Color fundus photograph; 848x848; modified Davis grading:
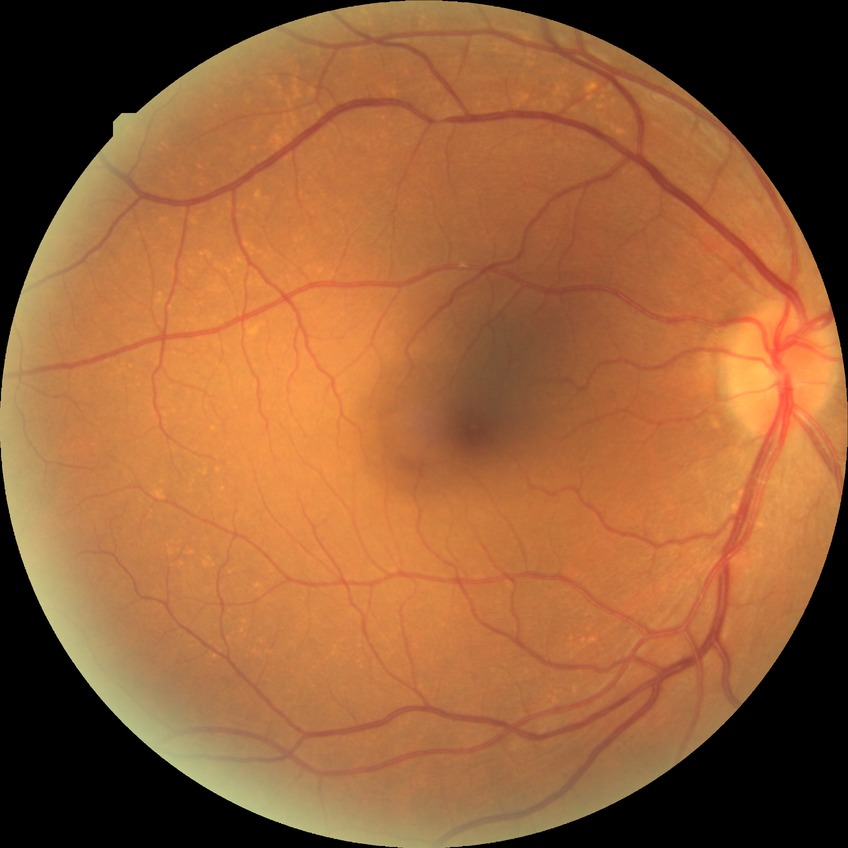
Modified Davis grading: no diabetic retinopathy.